Image size 848x848 · retinal fundus photograph:
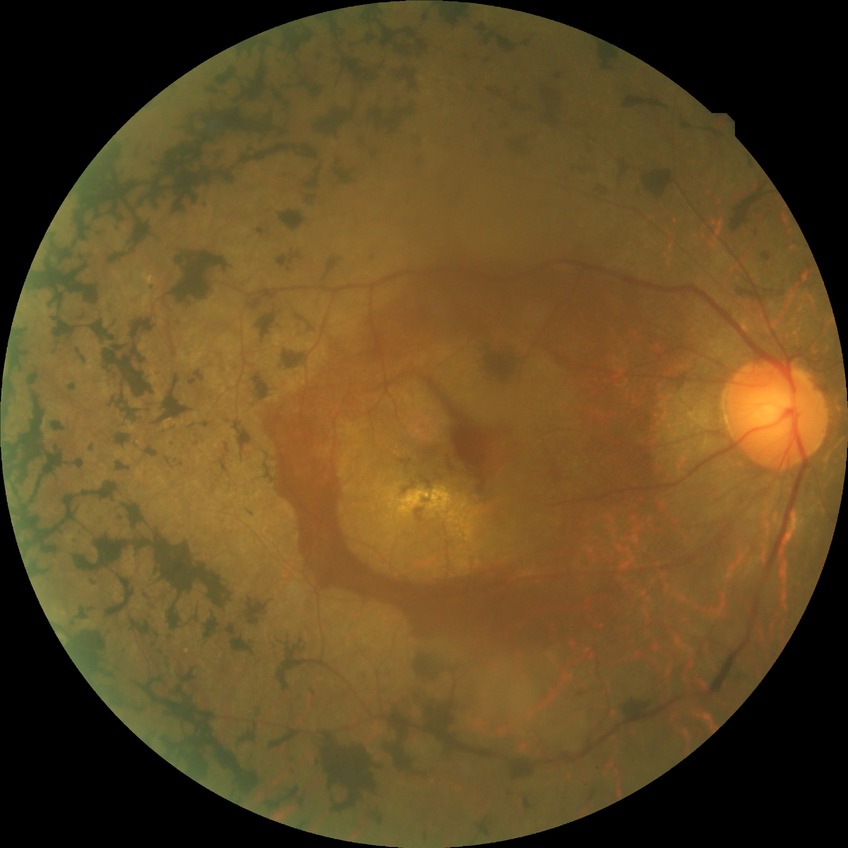

Diabetic retinopathy (DR) is NDR (no diabetic retinopathy).